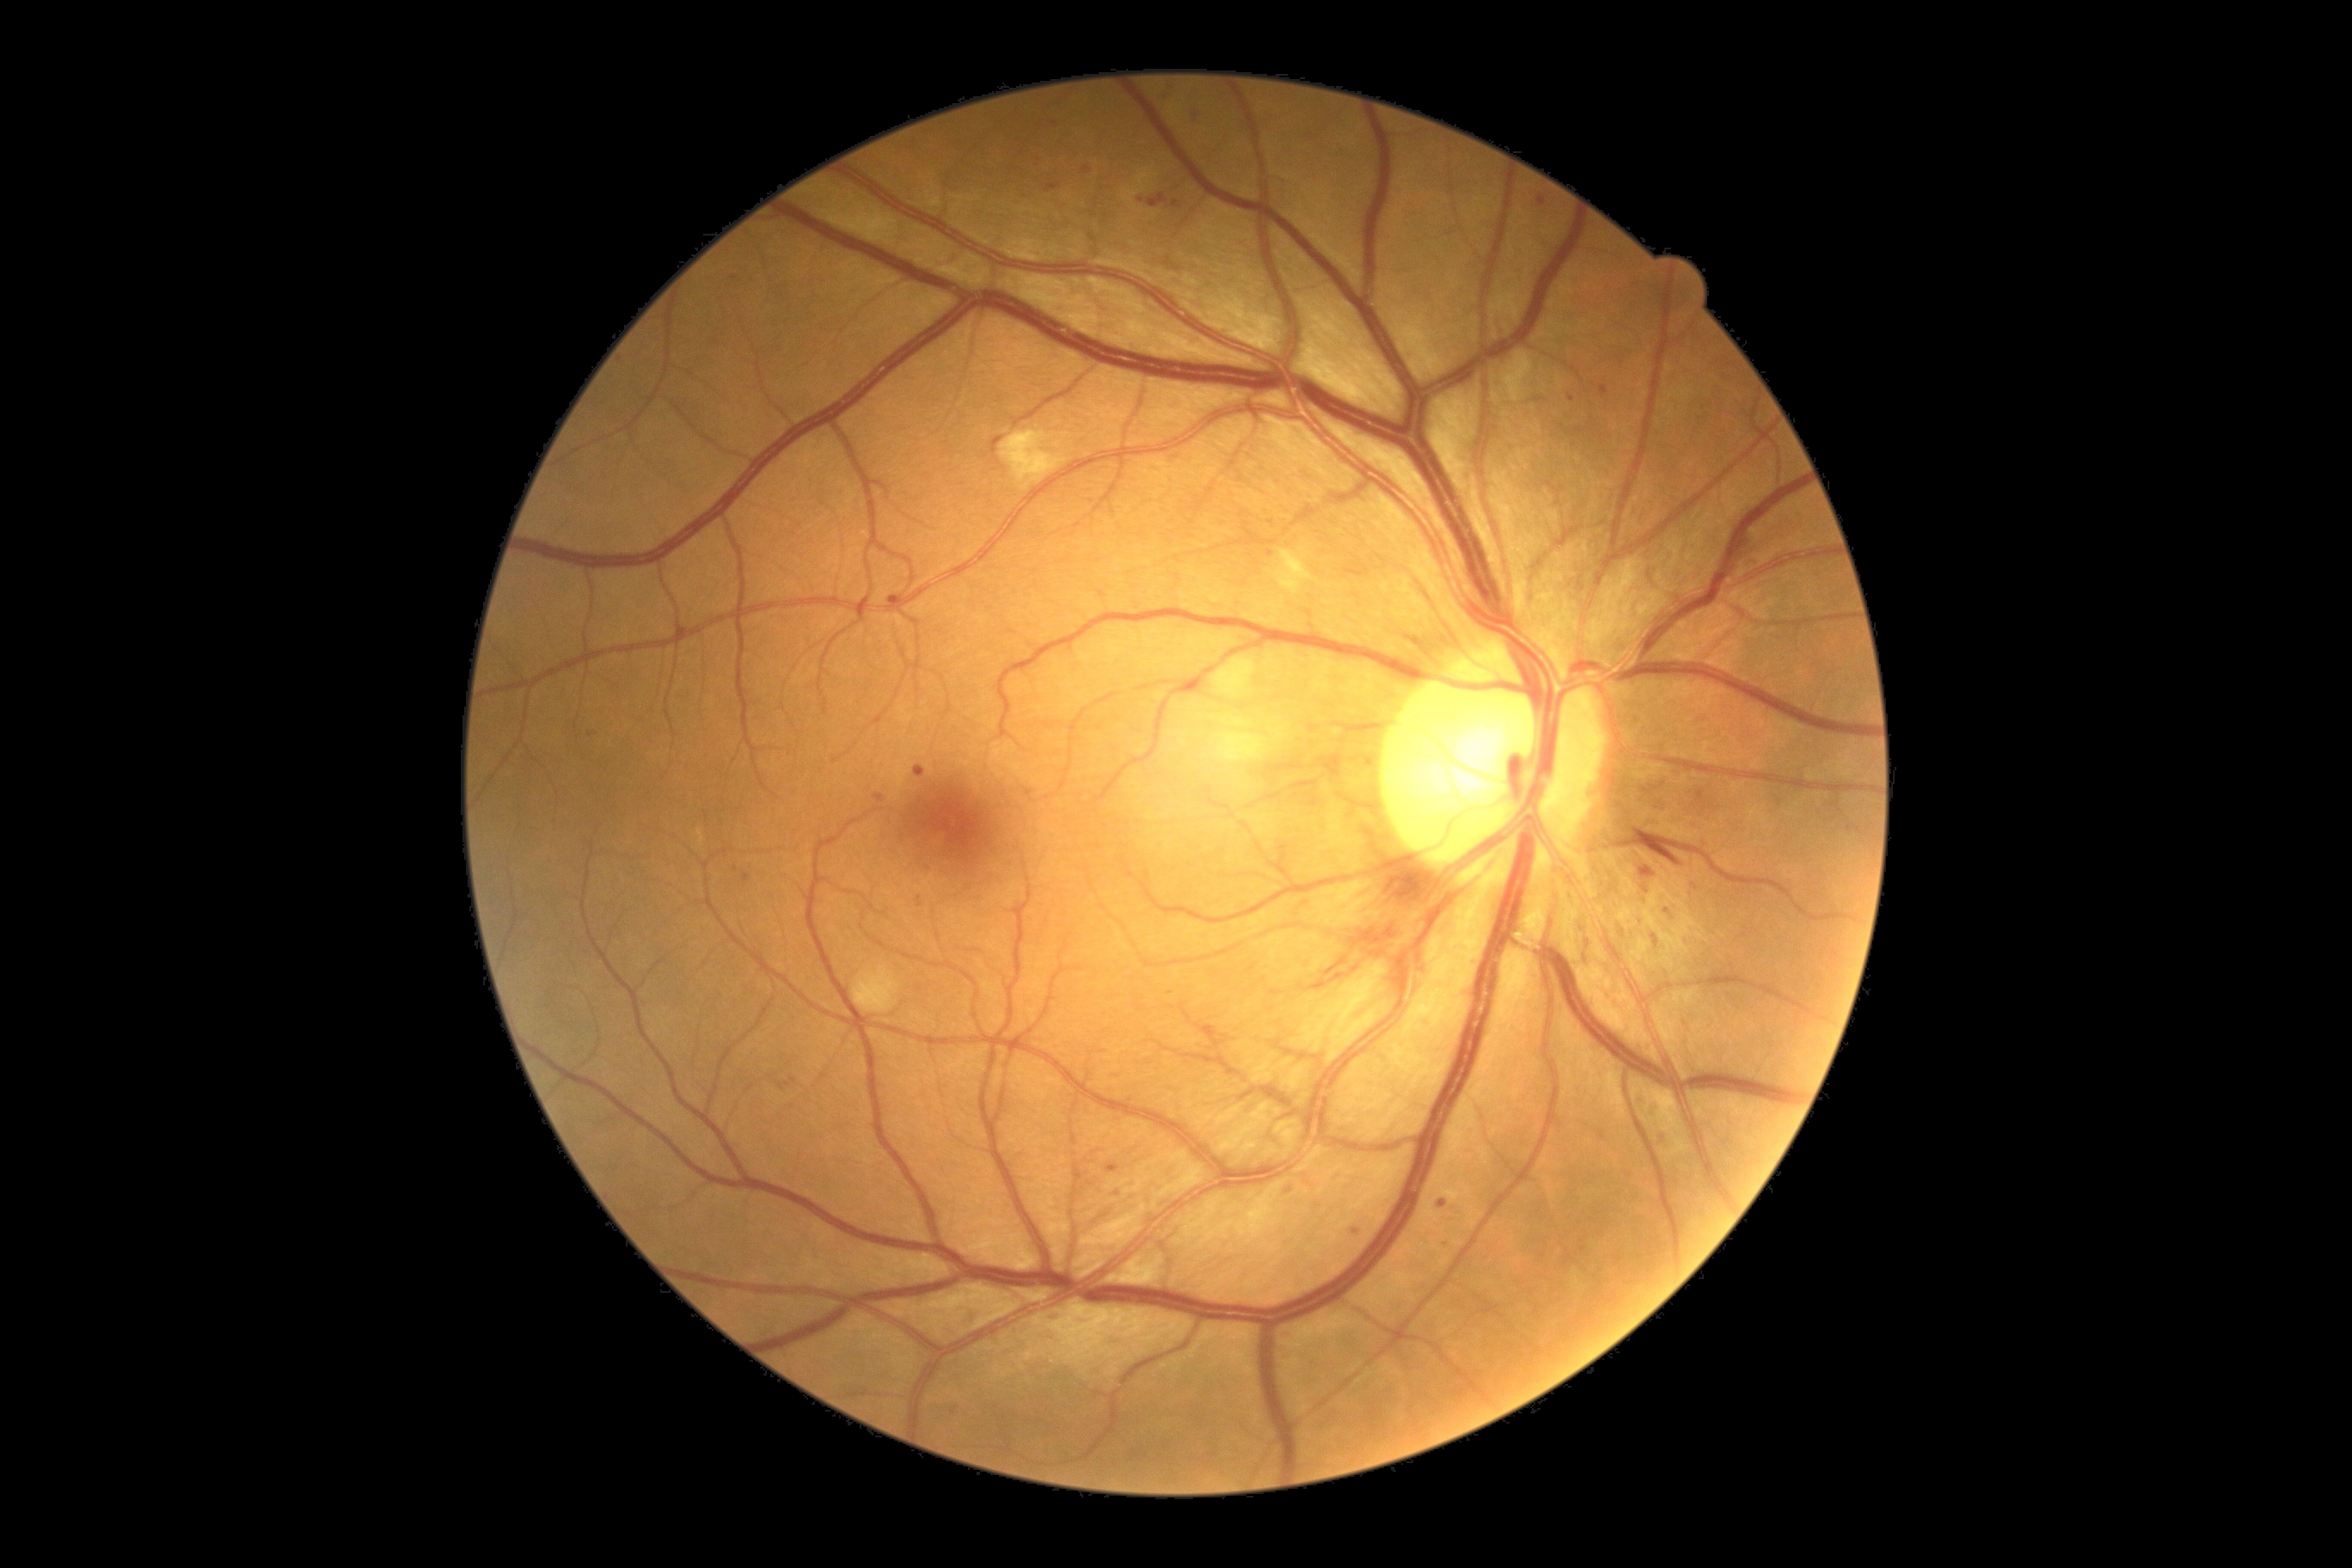
{"partial":true,"dr_grade":2,"dr_grade_name":"moderate NPDR","lesions":{"ma":[[1046,185,1060,192],[1638,917,1646,928],[964,1313,977,1328],[1641,785,1658,795],[1082,168,1093,175],[1639,866,1657,879],[1536,195,1547,207],[1600,1132,1607,1141],[916,766,924,778],[1650,1046,1653,1057],[888,596,898,604]],"ma_small":[[1141,200],[1646,889],[1443,1204],[1840,812],[735,870],[1195,116],[1695,887]]}}